848 by 848 pixels.
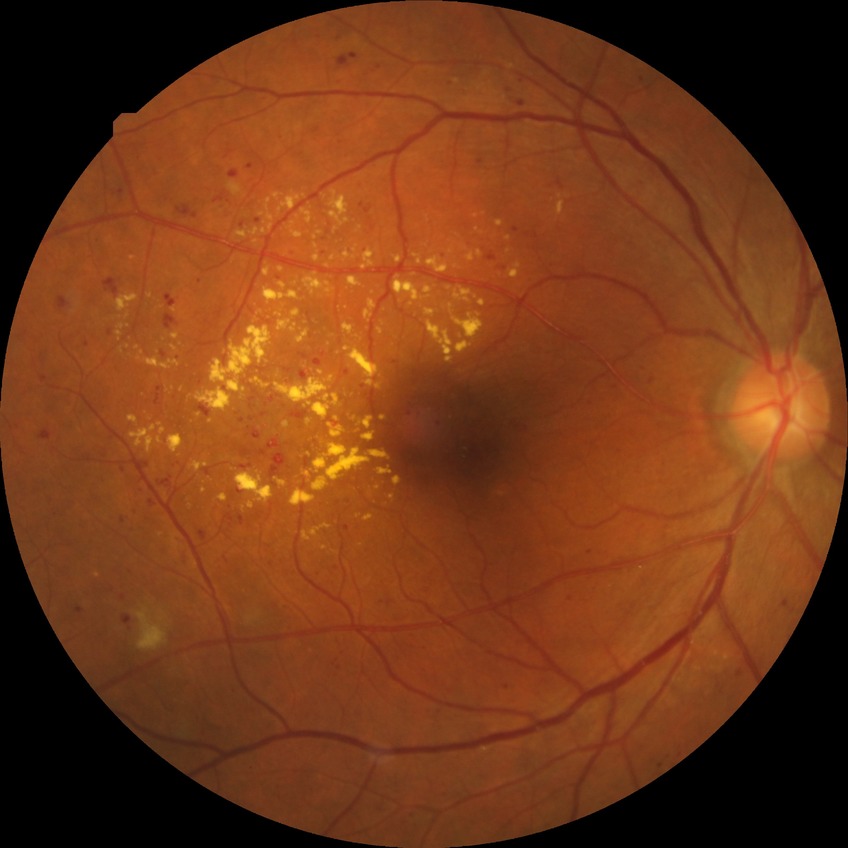

DR severity=PPDR.